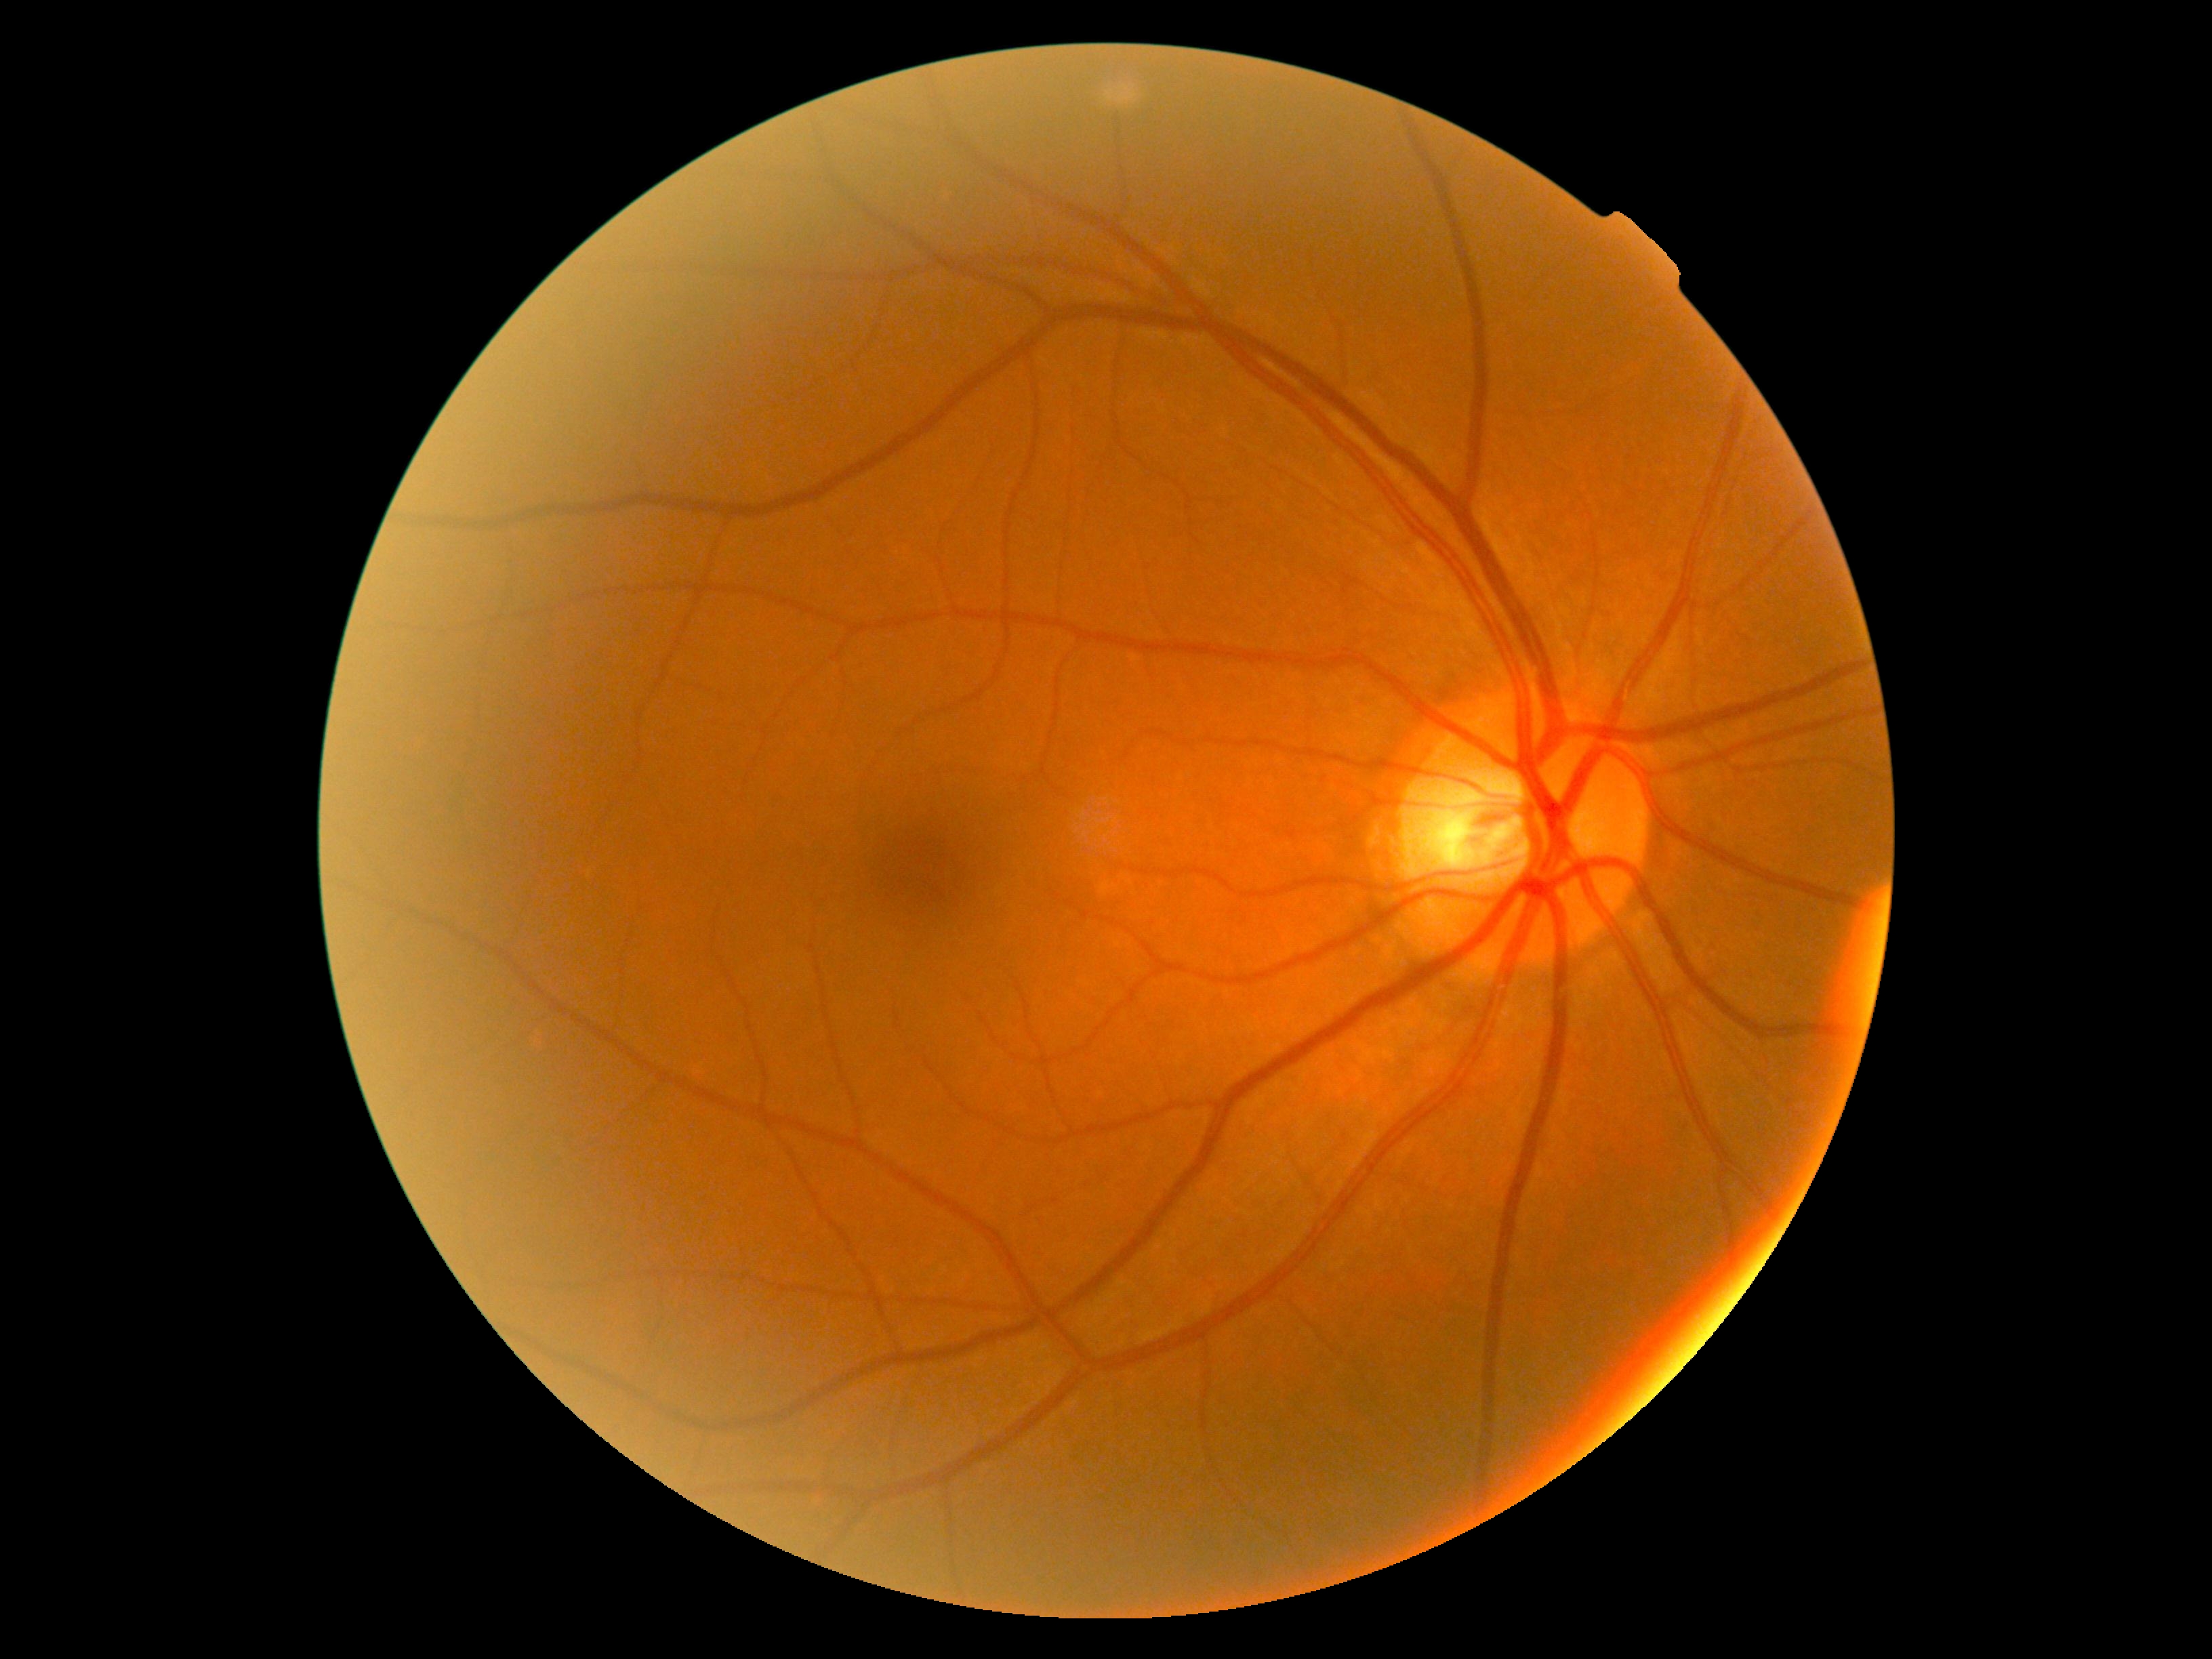
Diabetic retinopathy is grade 0 (no apparent retinopathy).